Captured on a Remidio Fundus on Phone (FOP) camera, 1659 by 2212 pixels
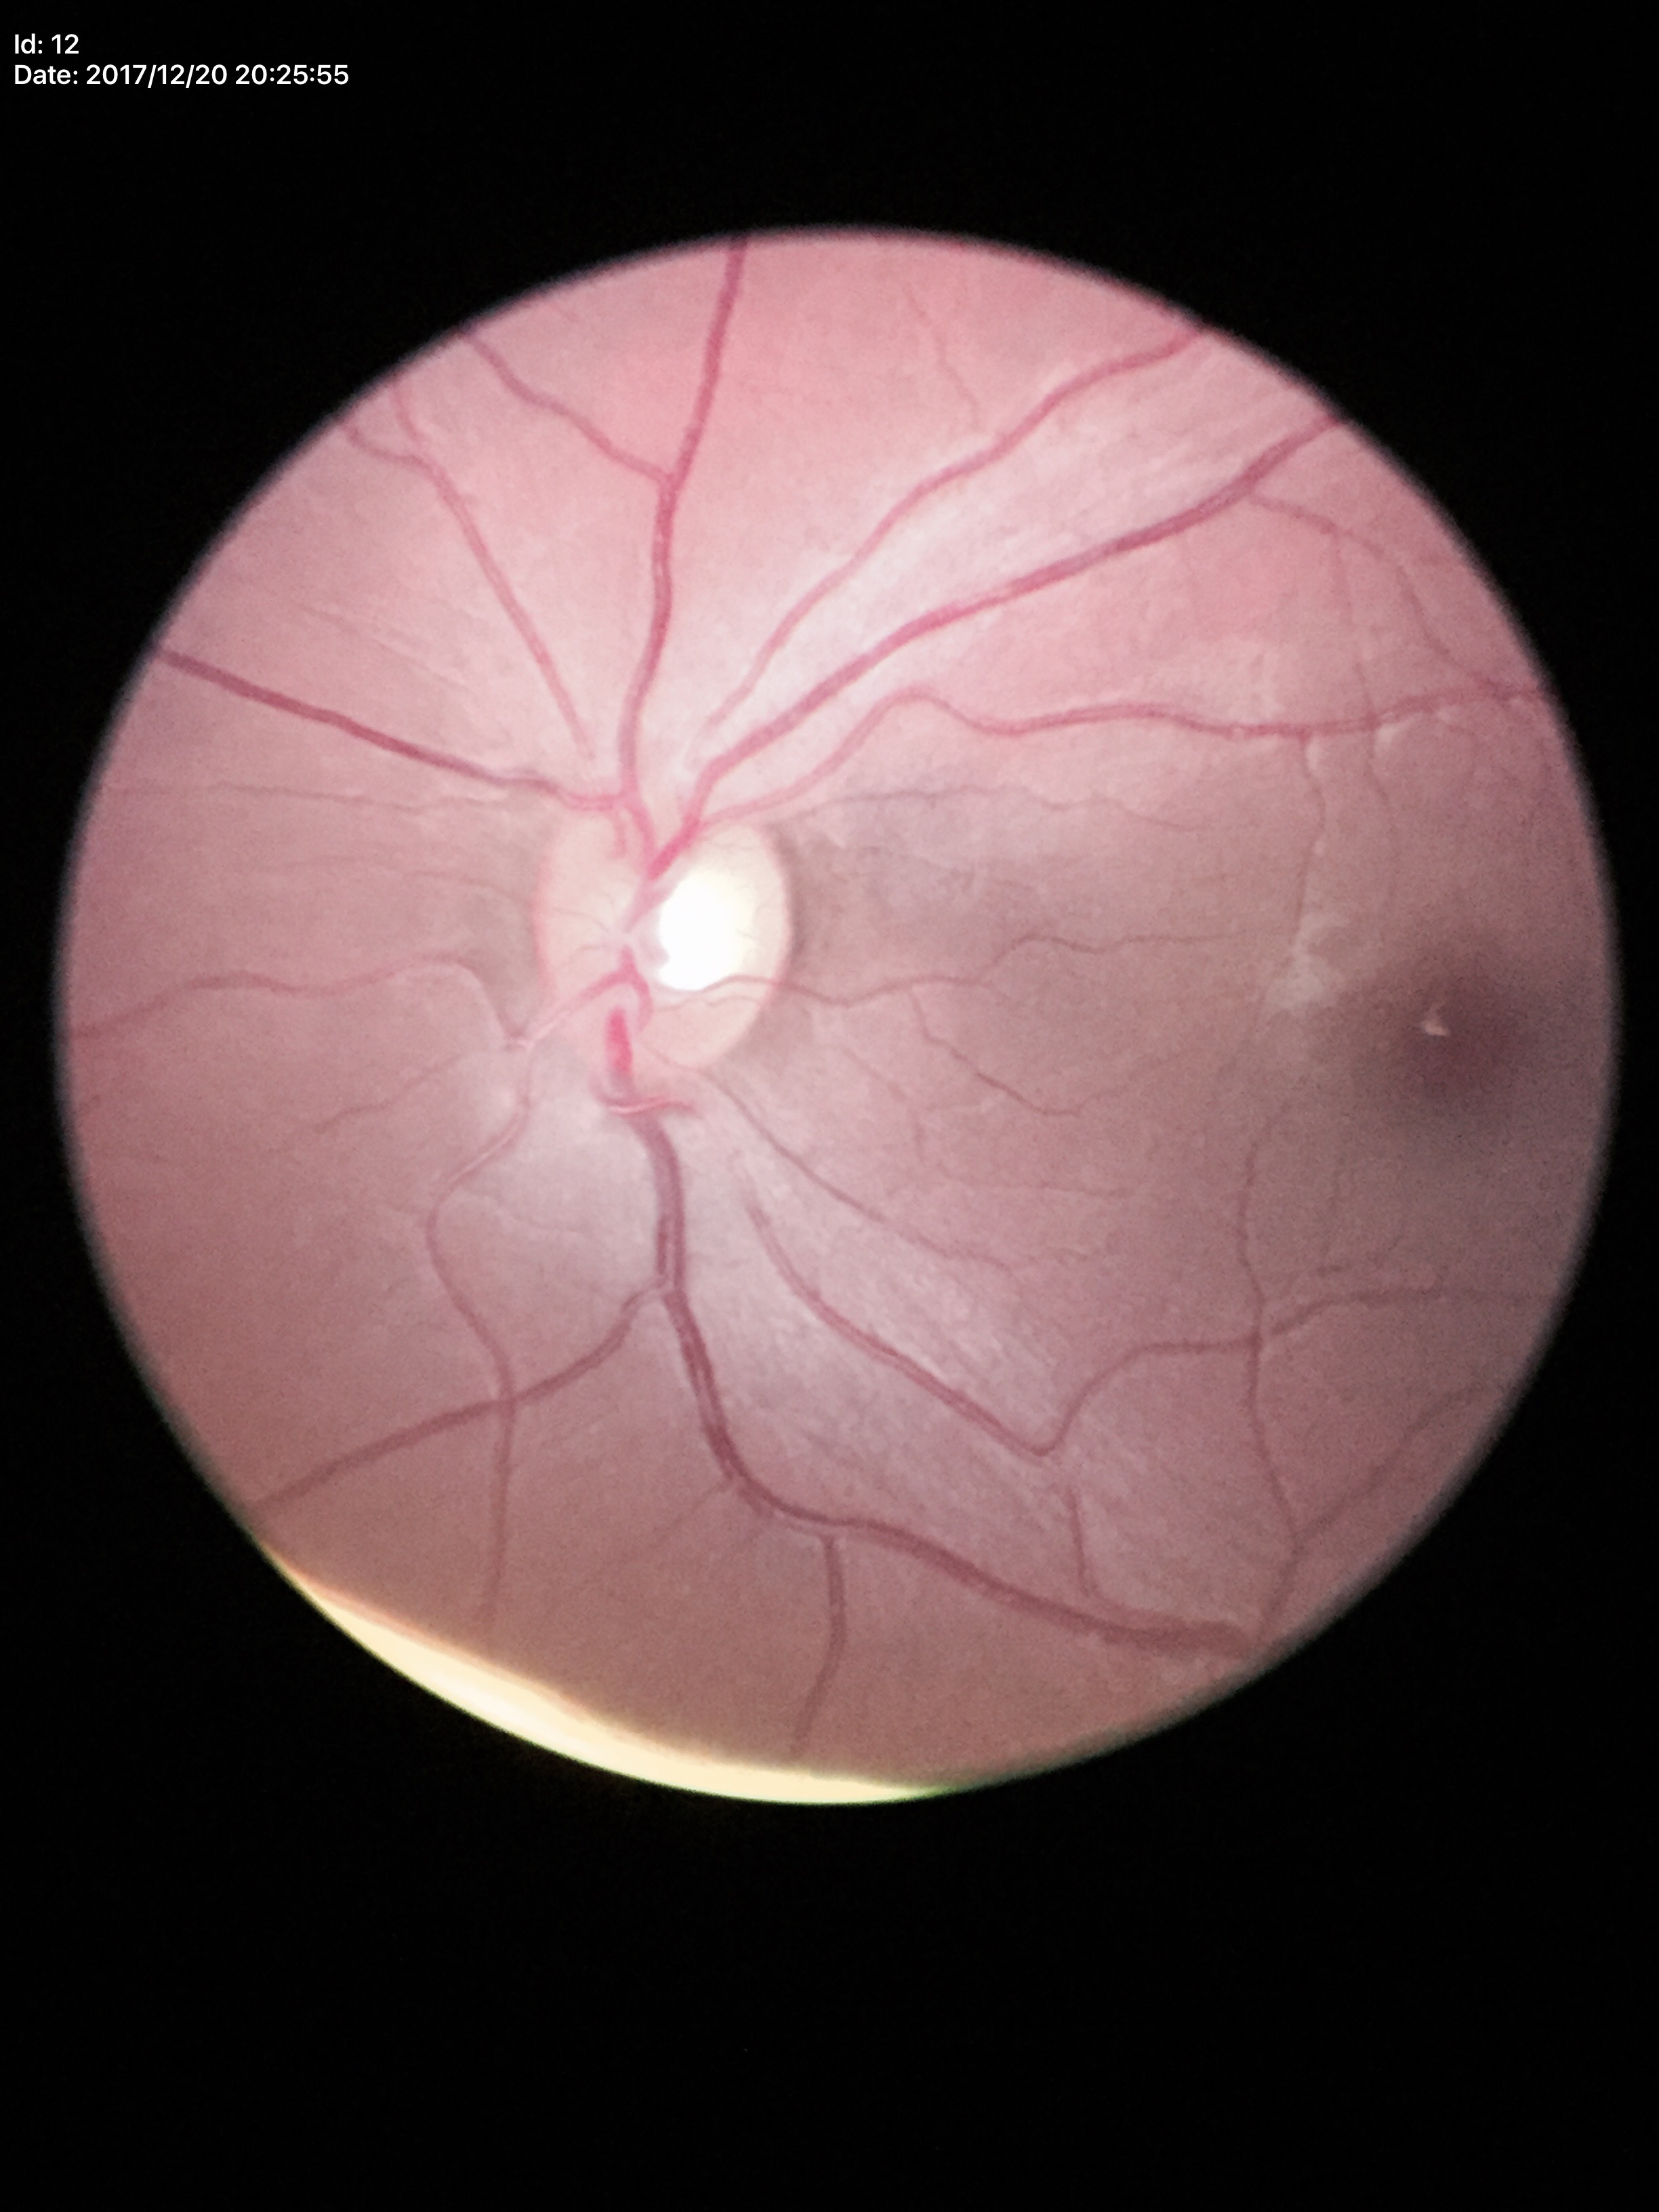 Vertical C/D ratio (VCDR) is 0.52.
No glaucomatous optic neuropathy.